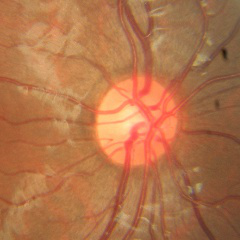 Glaucoma diagnosis: no glaucomatous changes.